2212x1659px, 45-degree field of view:
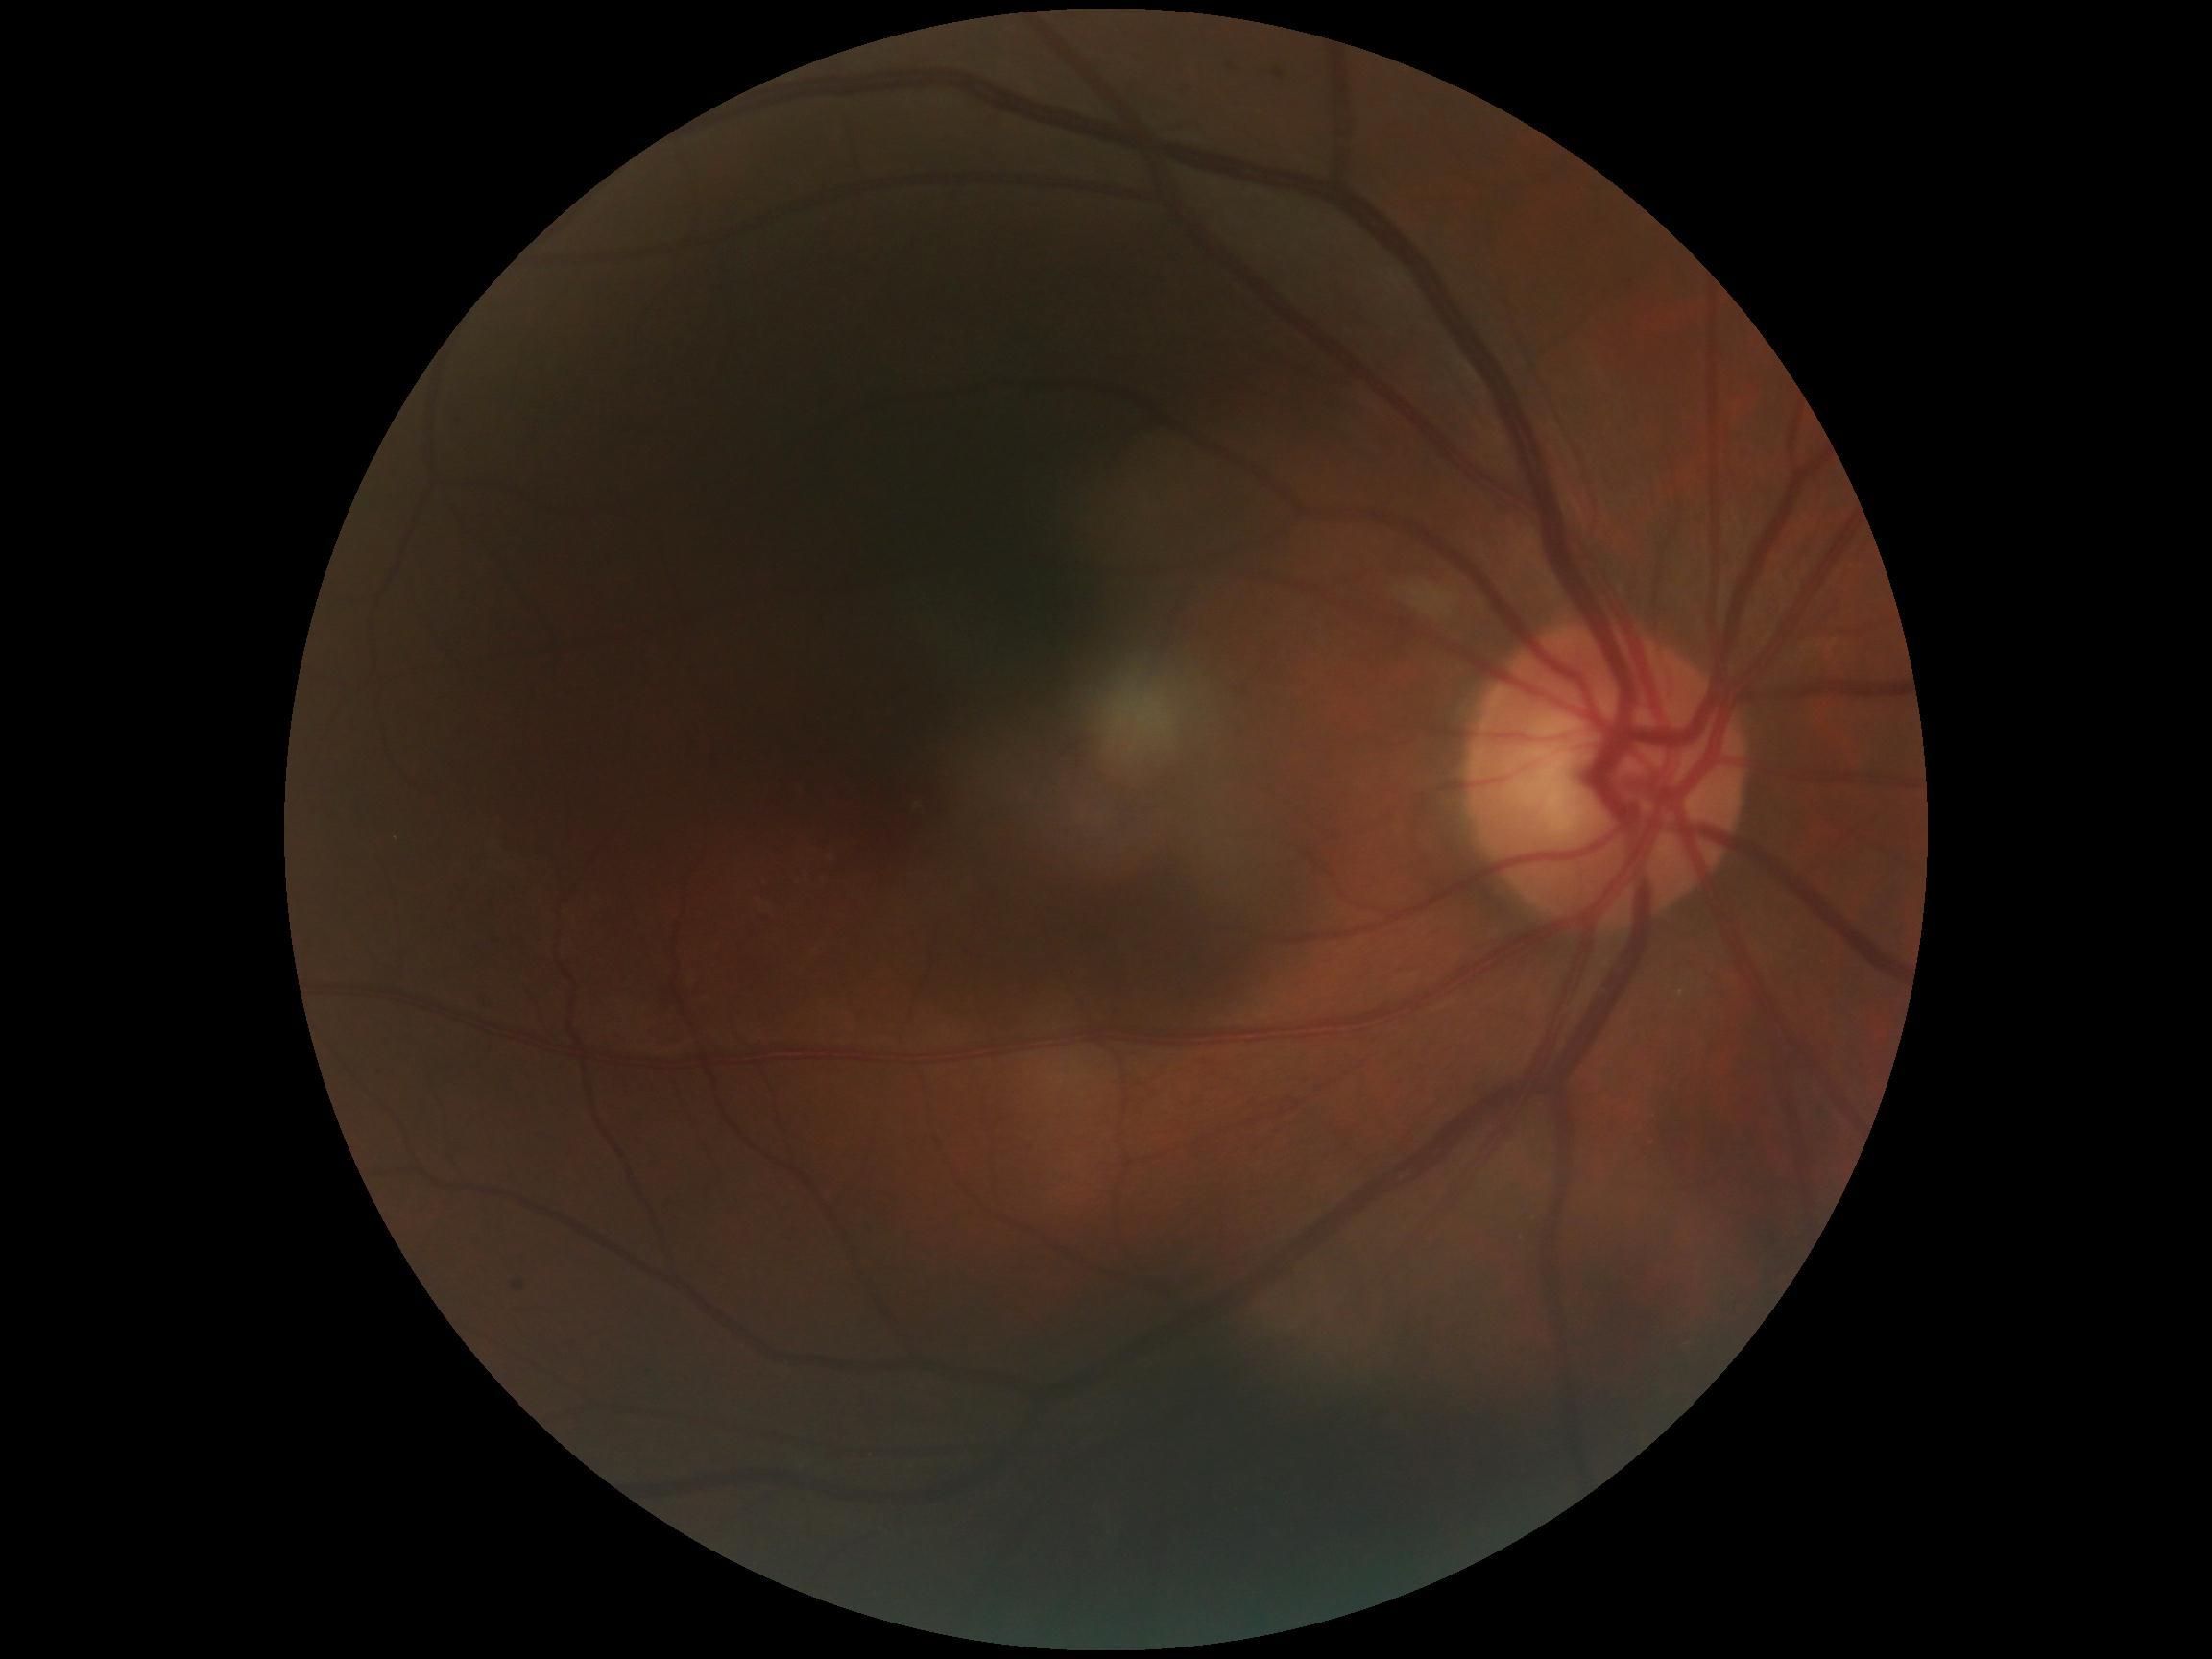 The retinopathy is classified as non-proliferative diabetic retinopathy. DR stage is 1/4.